Color fundus image: 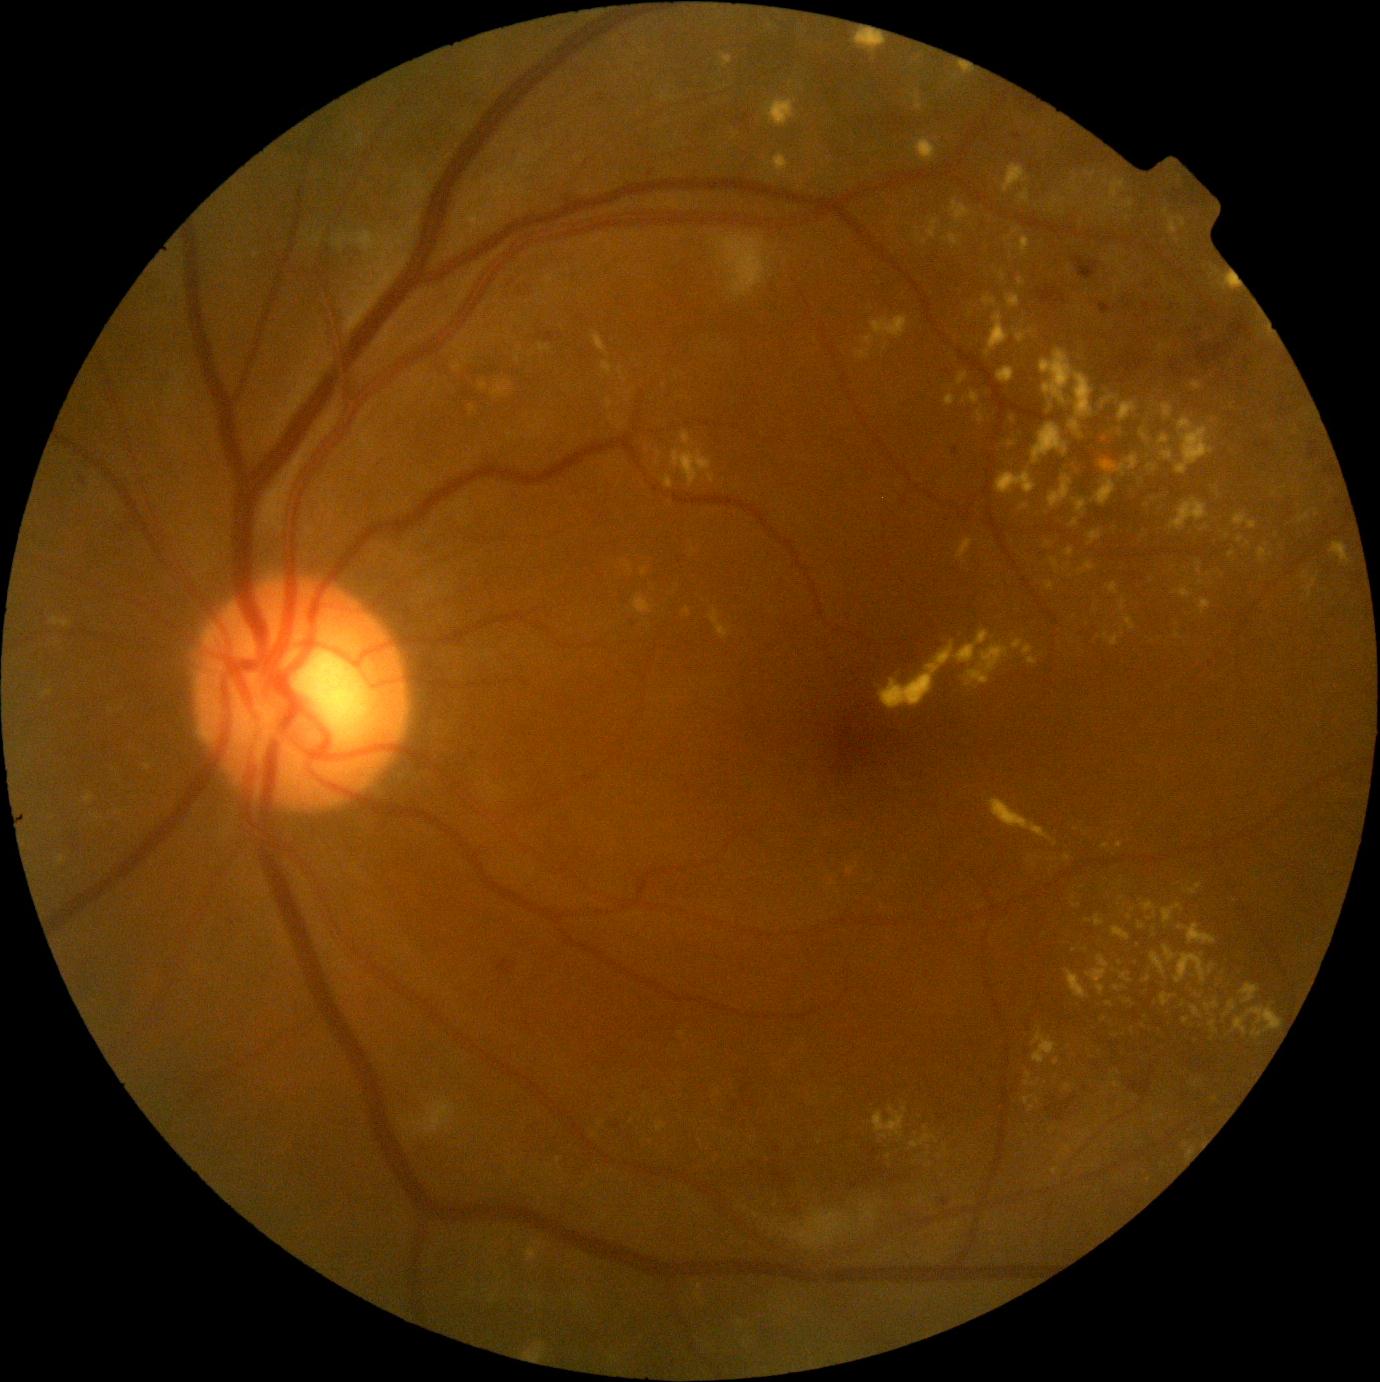 DR stage is moderate non-proliferative diabetic retinopathy (grade 2).